Phoenix ICON wide-field infant fundus image: 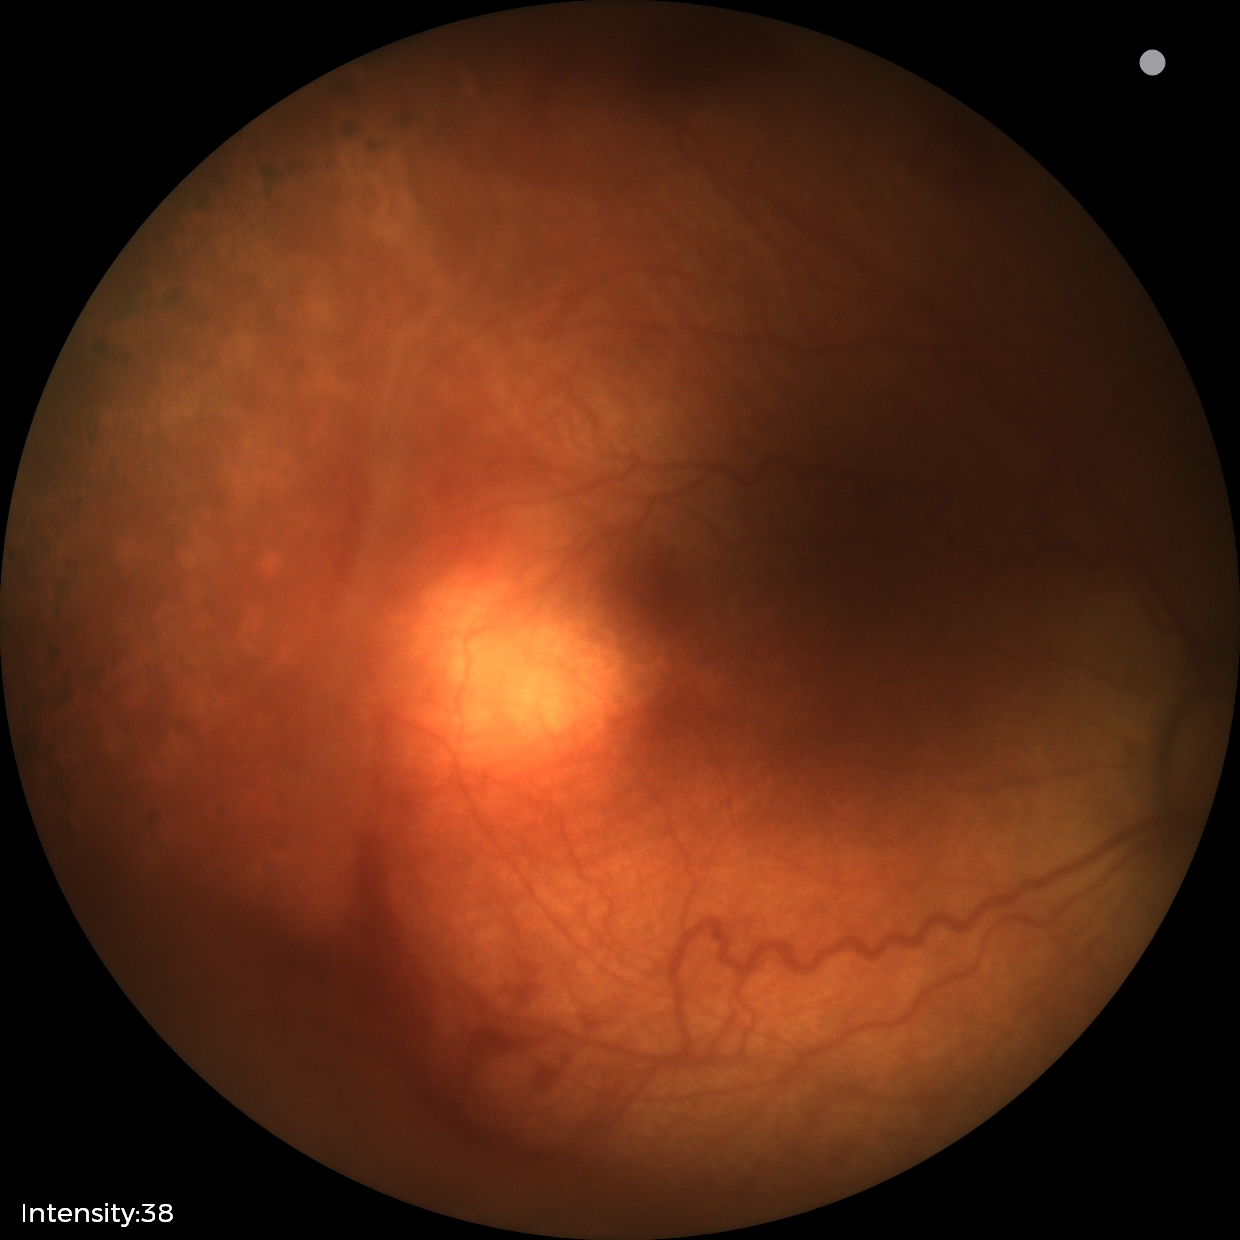

Screening: no plus disease | status post ROP.